848 x 848 pixels · diabetic retinopathy graded by the modified Davis classification · color fundus image: 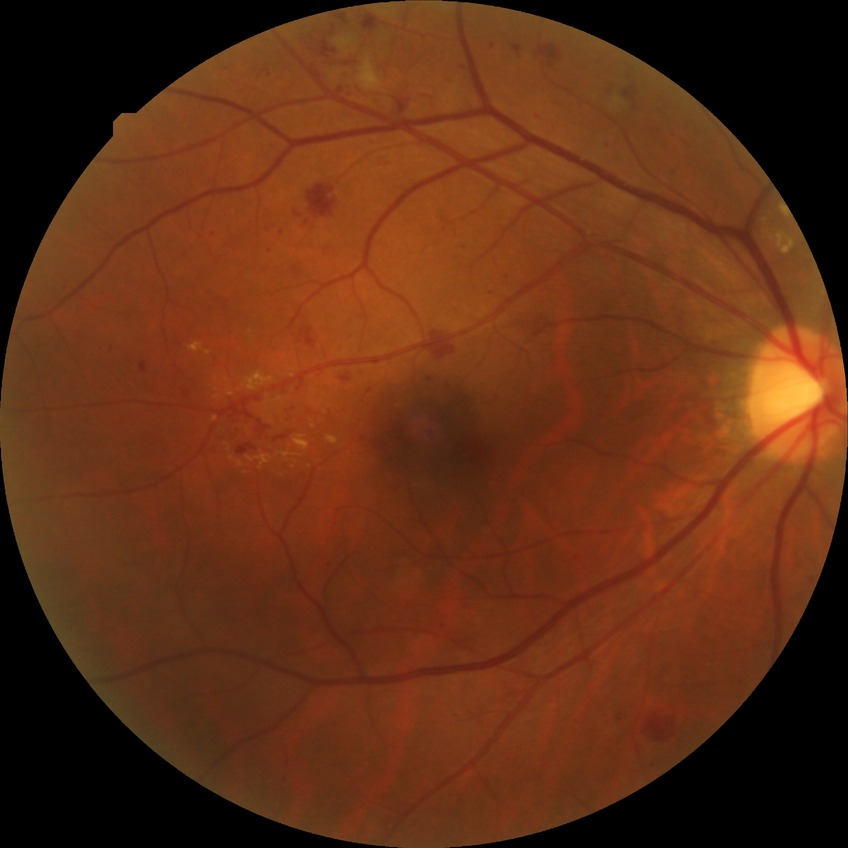 DR severity@PPDR.